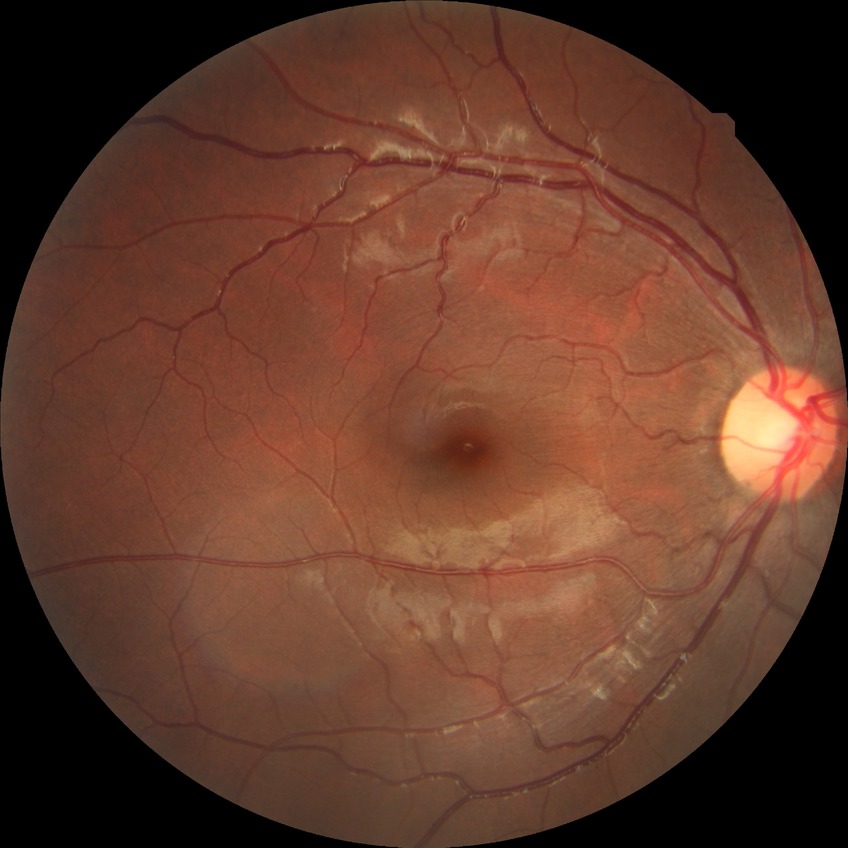 Diabetic retinopathy severity: no diabetic retinopathy.